Optic disc-centered crop:
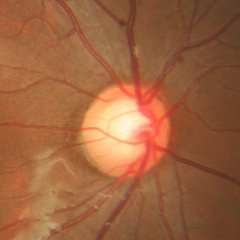 Optic disc photograph demonstrating no signs of glaucoma.